Image size 512x512:
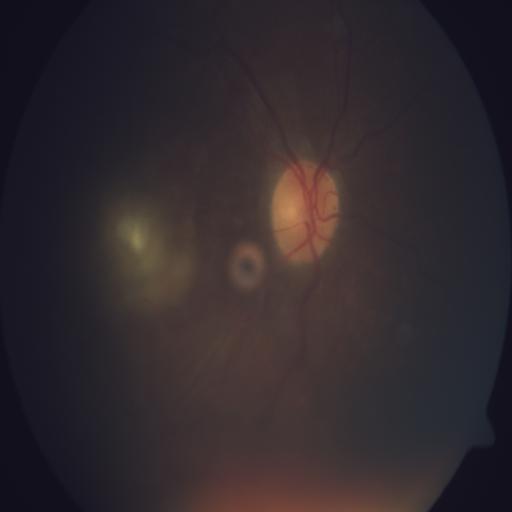 This fundus photograph shows optic disc pallor.